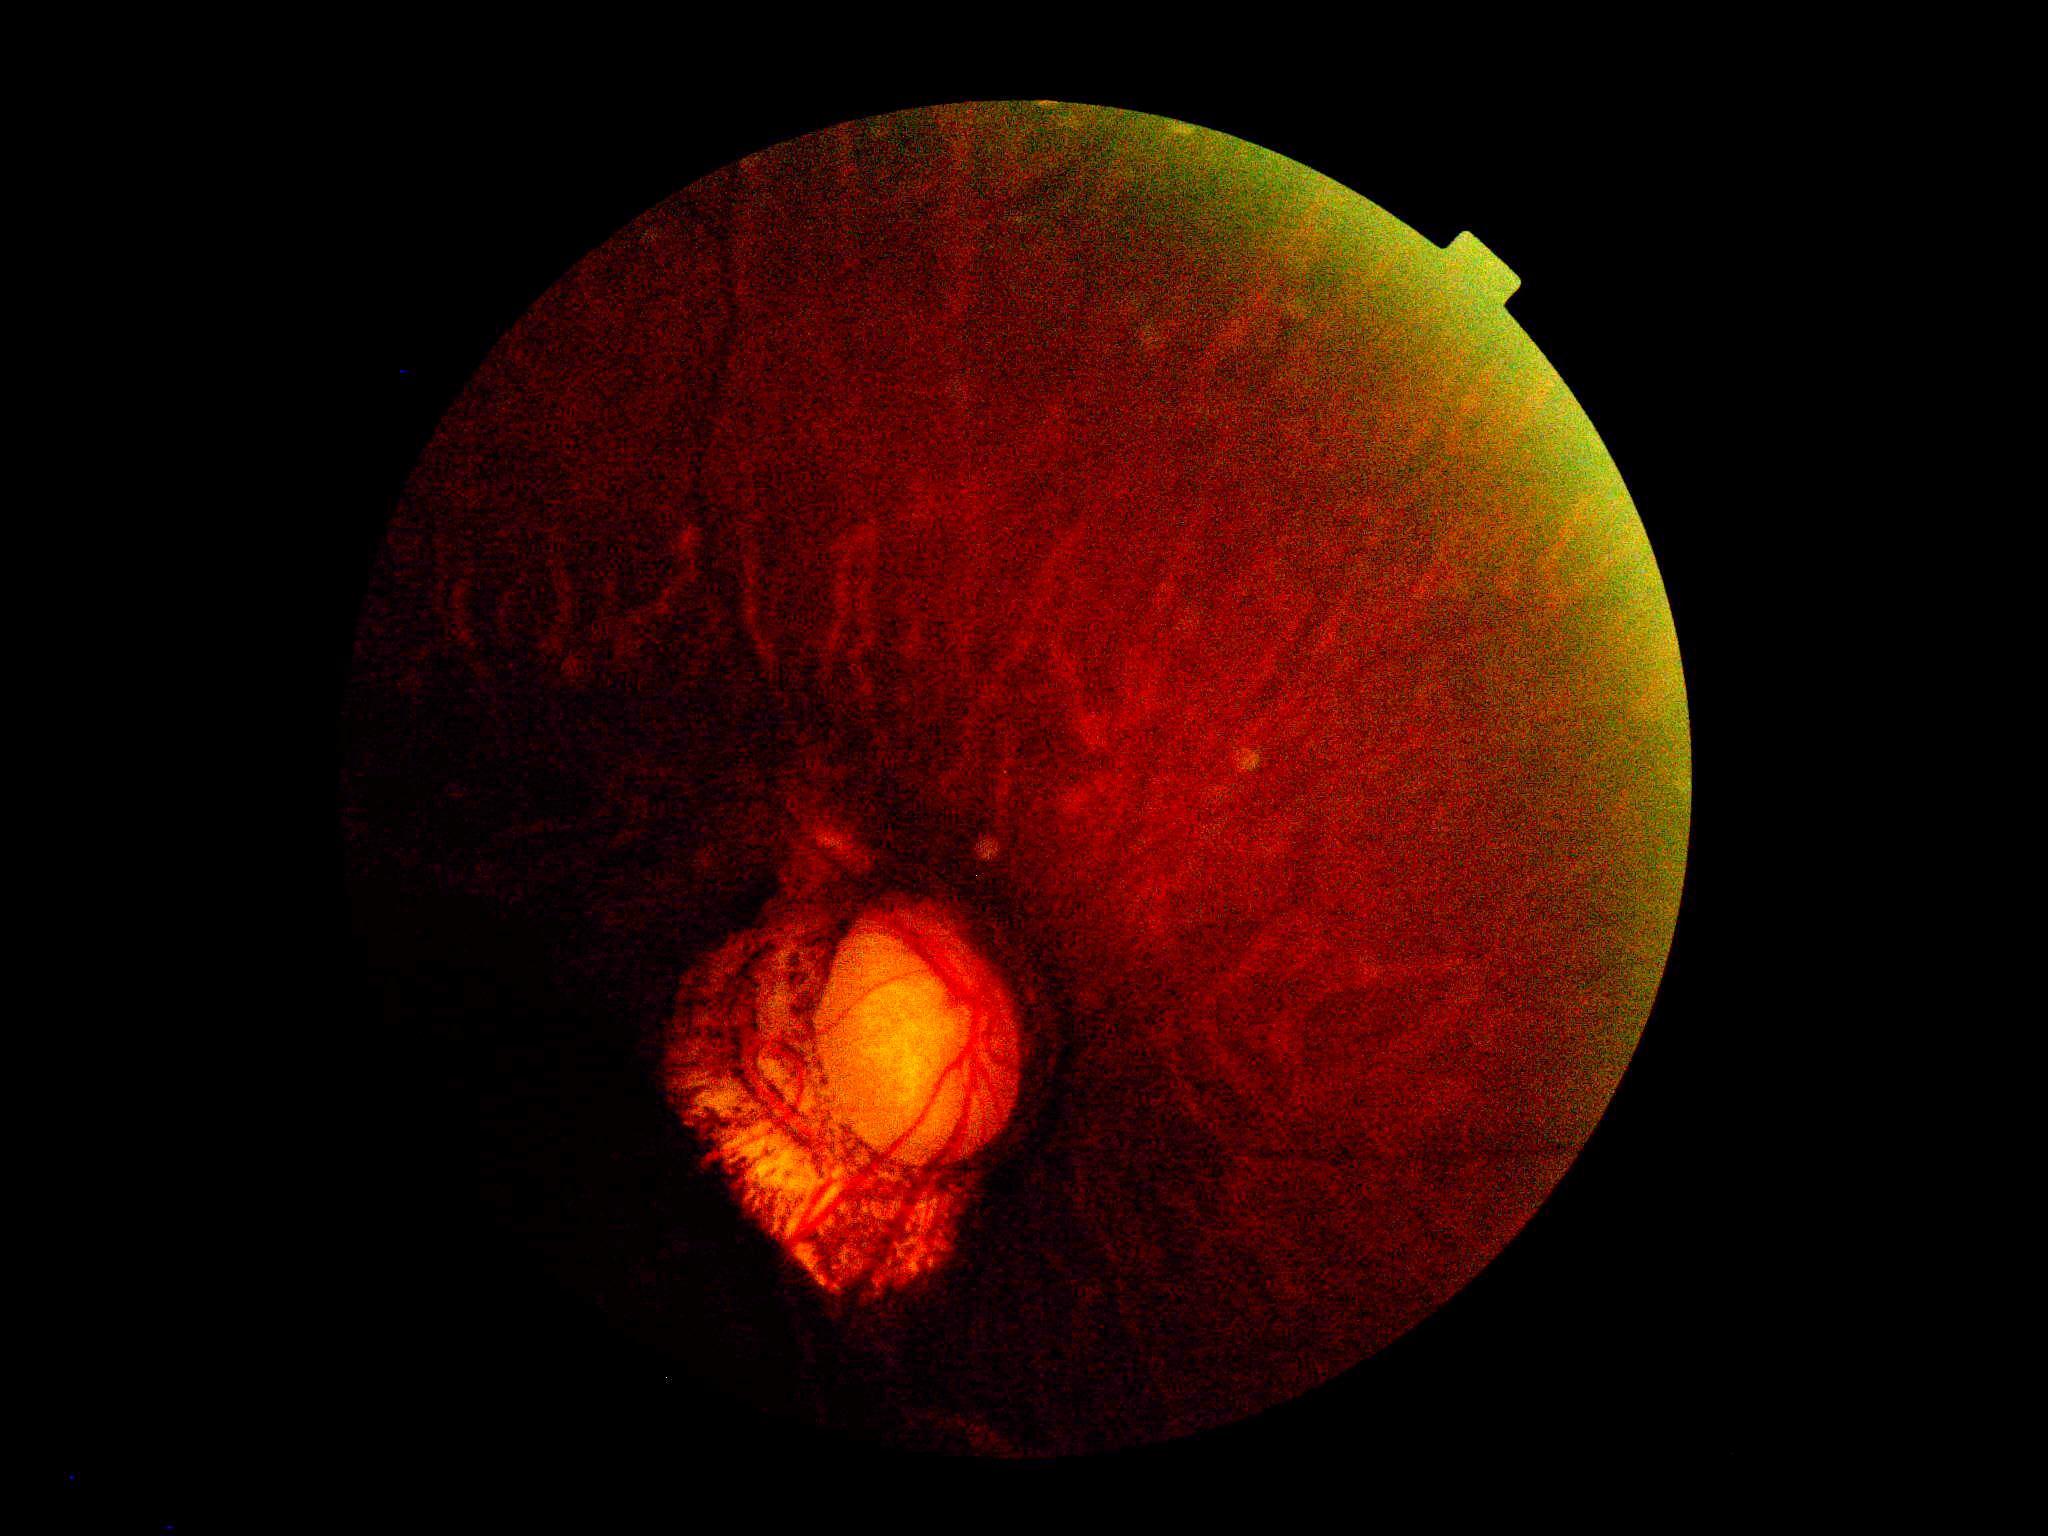

{"dr_grade": "ungradable"}